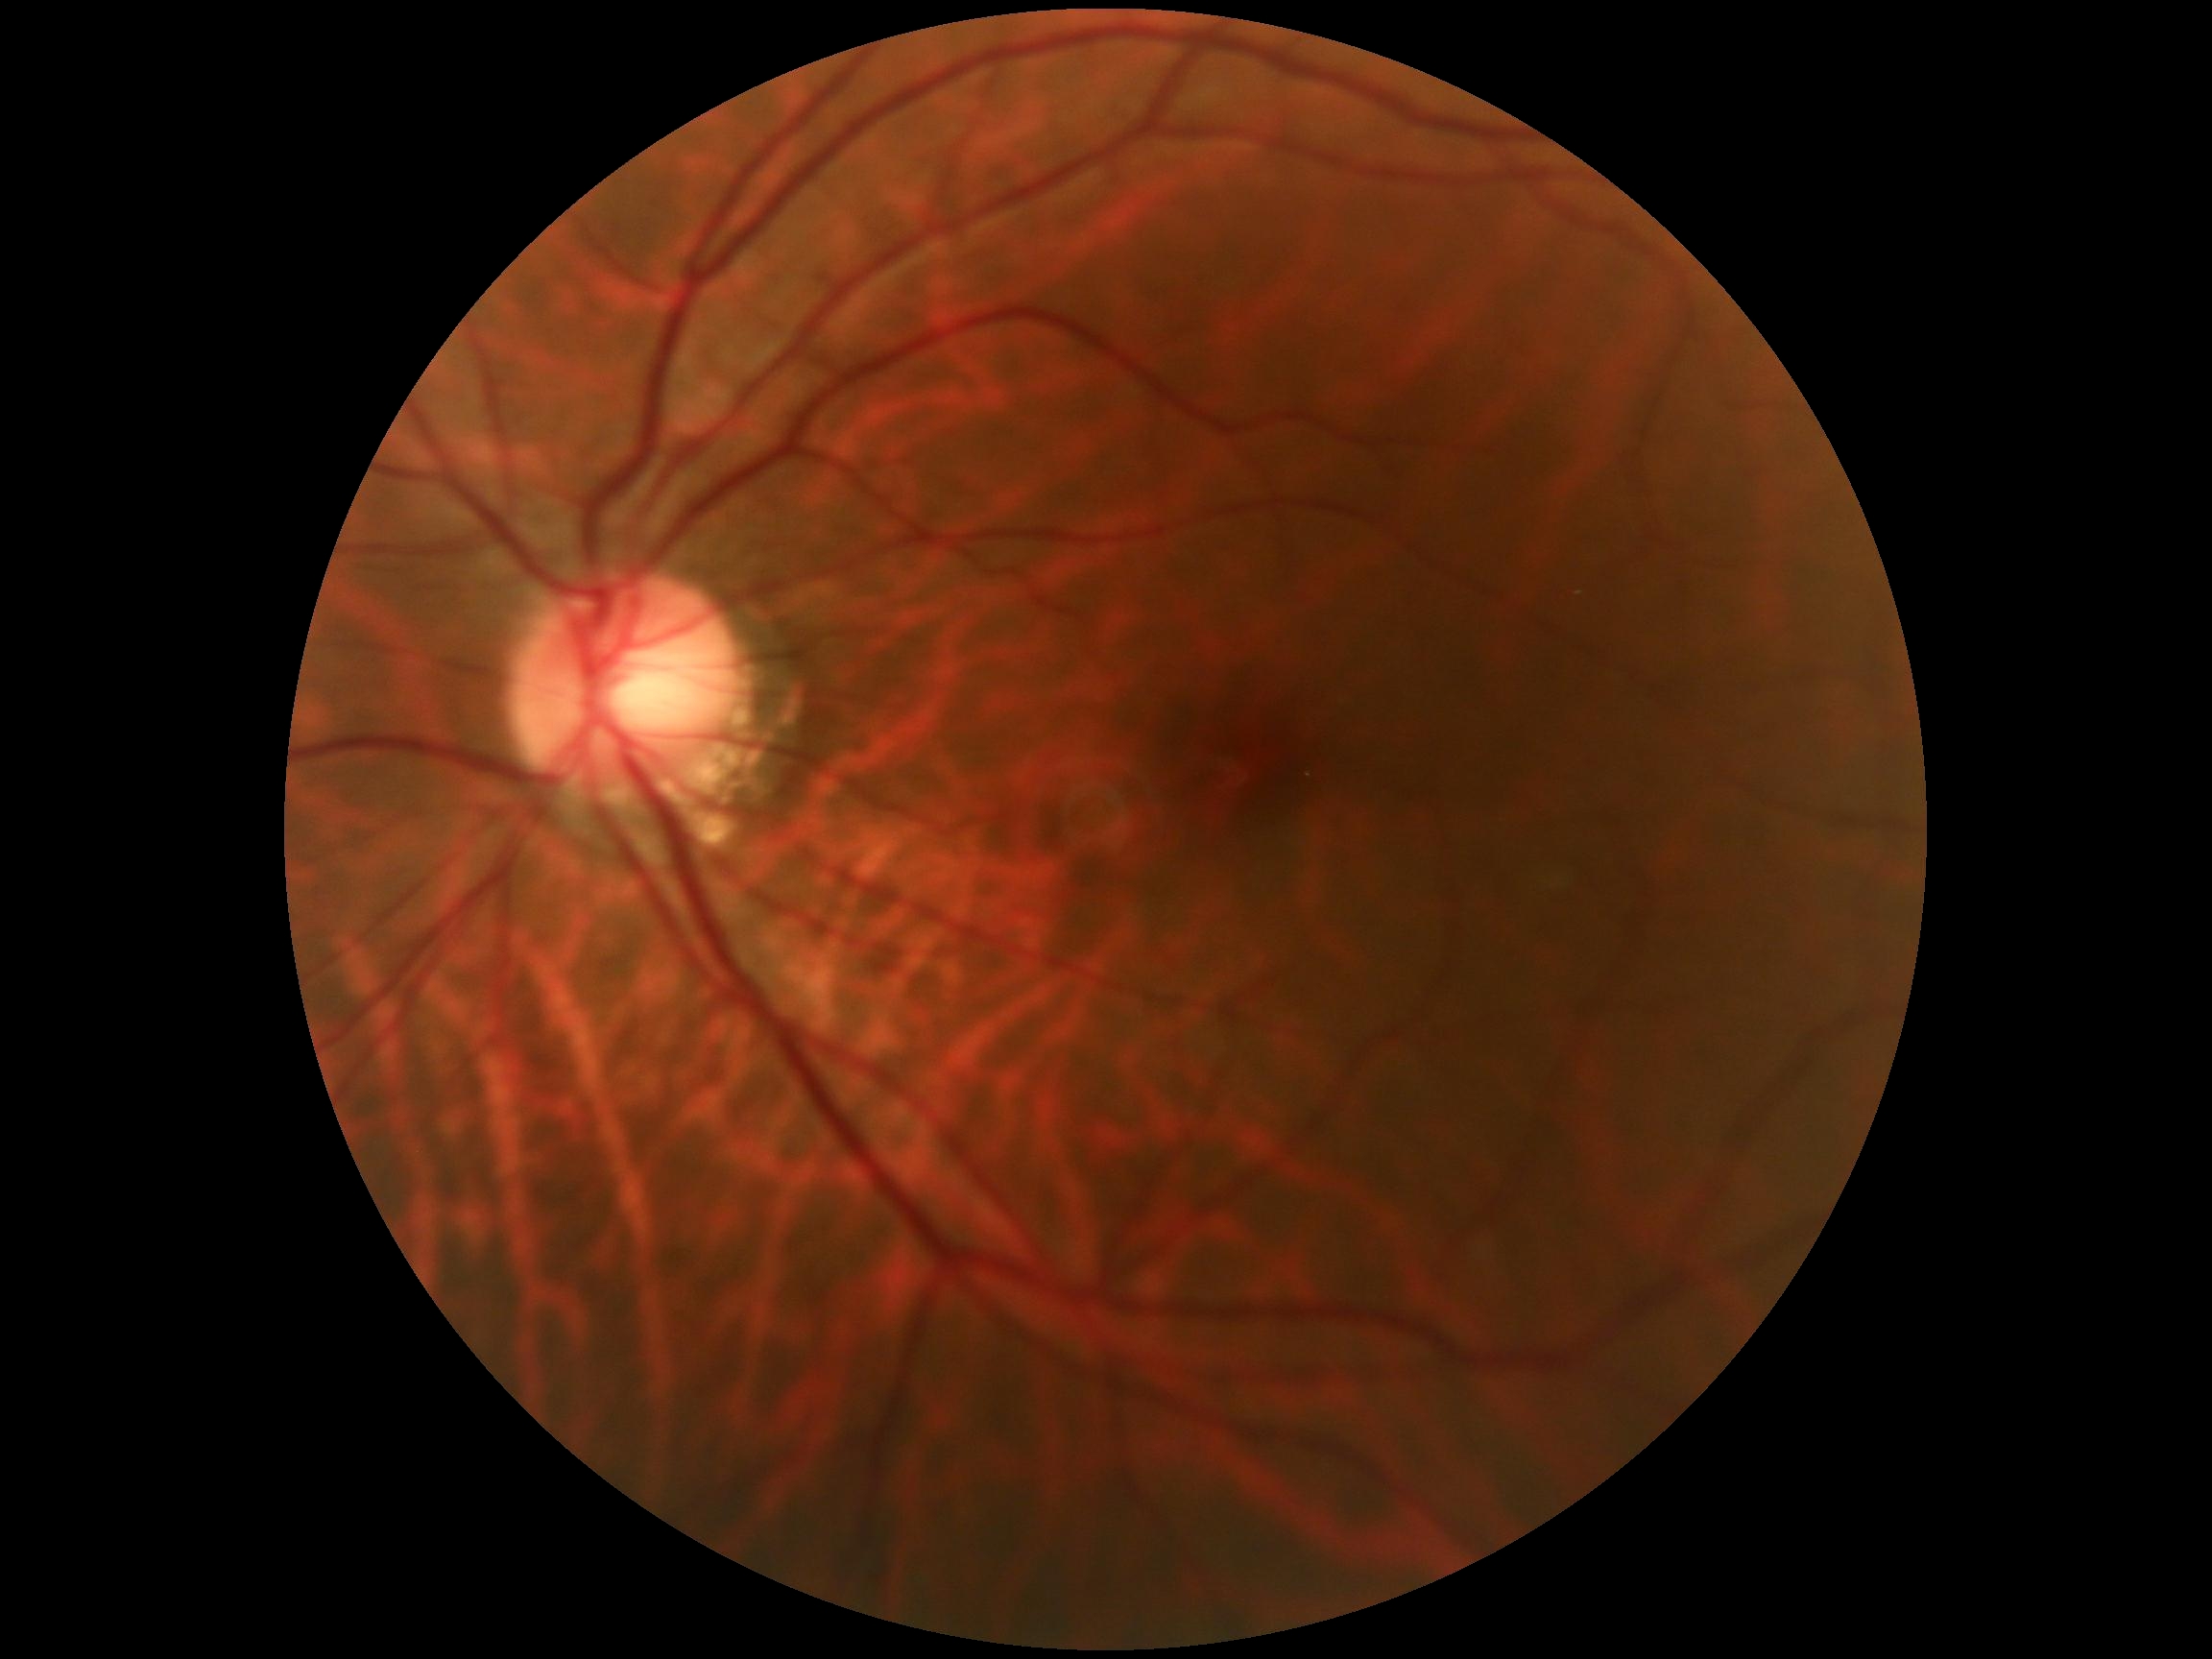
Diabetic retinopathy (DR): no apparent retinopathy (grade 0).